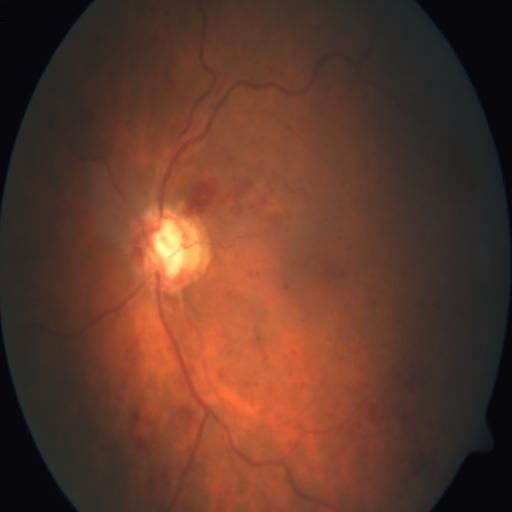
Fundus image with findings of central retinal vein occlusion.